Retinal fundus photograph · FOV: 45 degrees · camera: NIDEK AFC-230 · modified Davis classification · without pupil dilation.
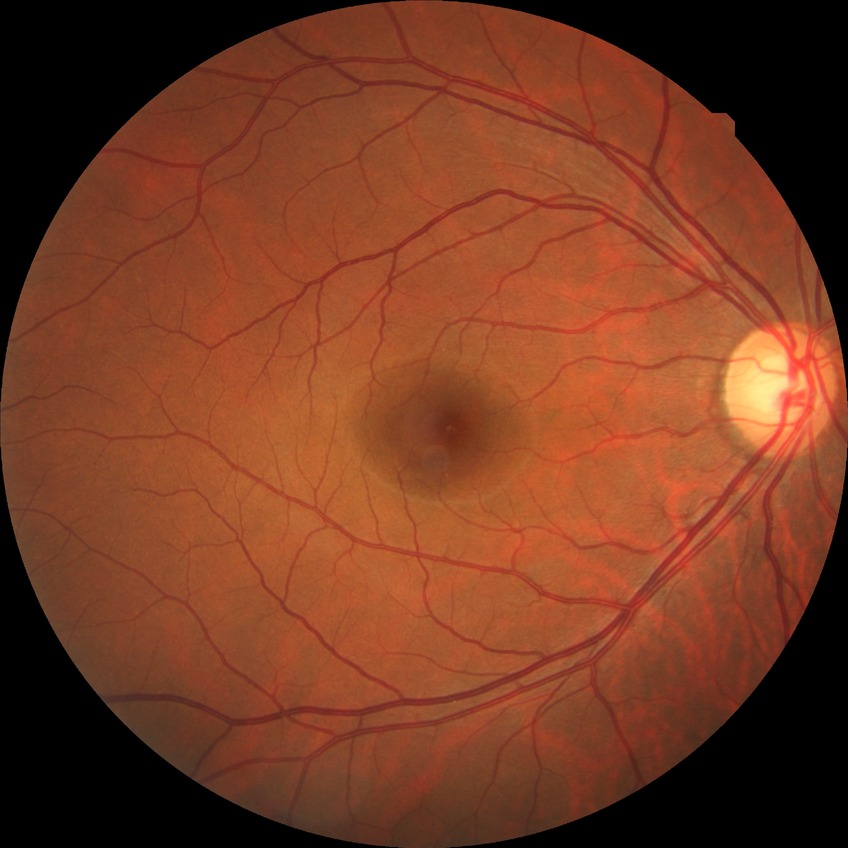

diabetic retinopathy (DR): NDR (no diabetic retinopathy).